2352x1568px.
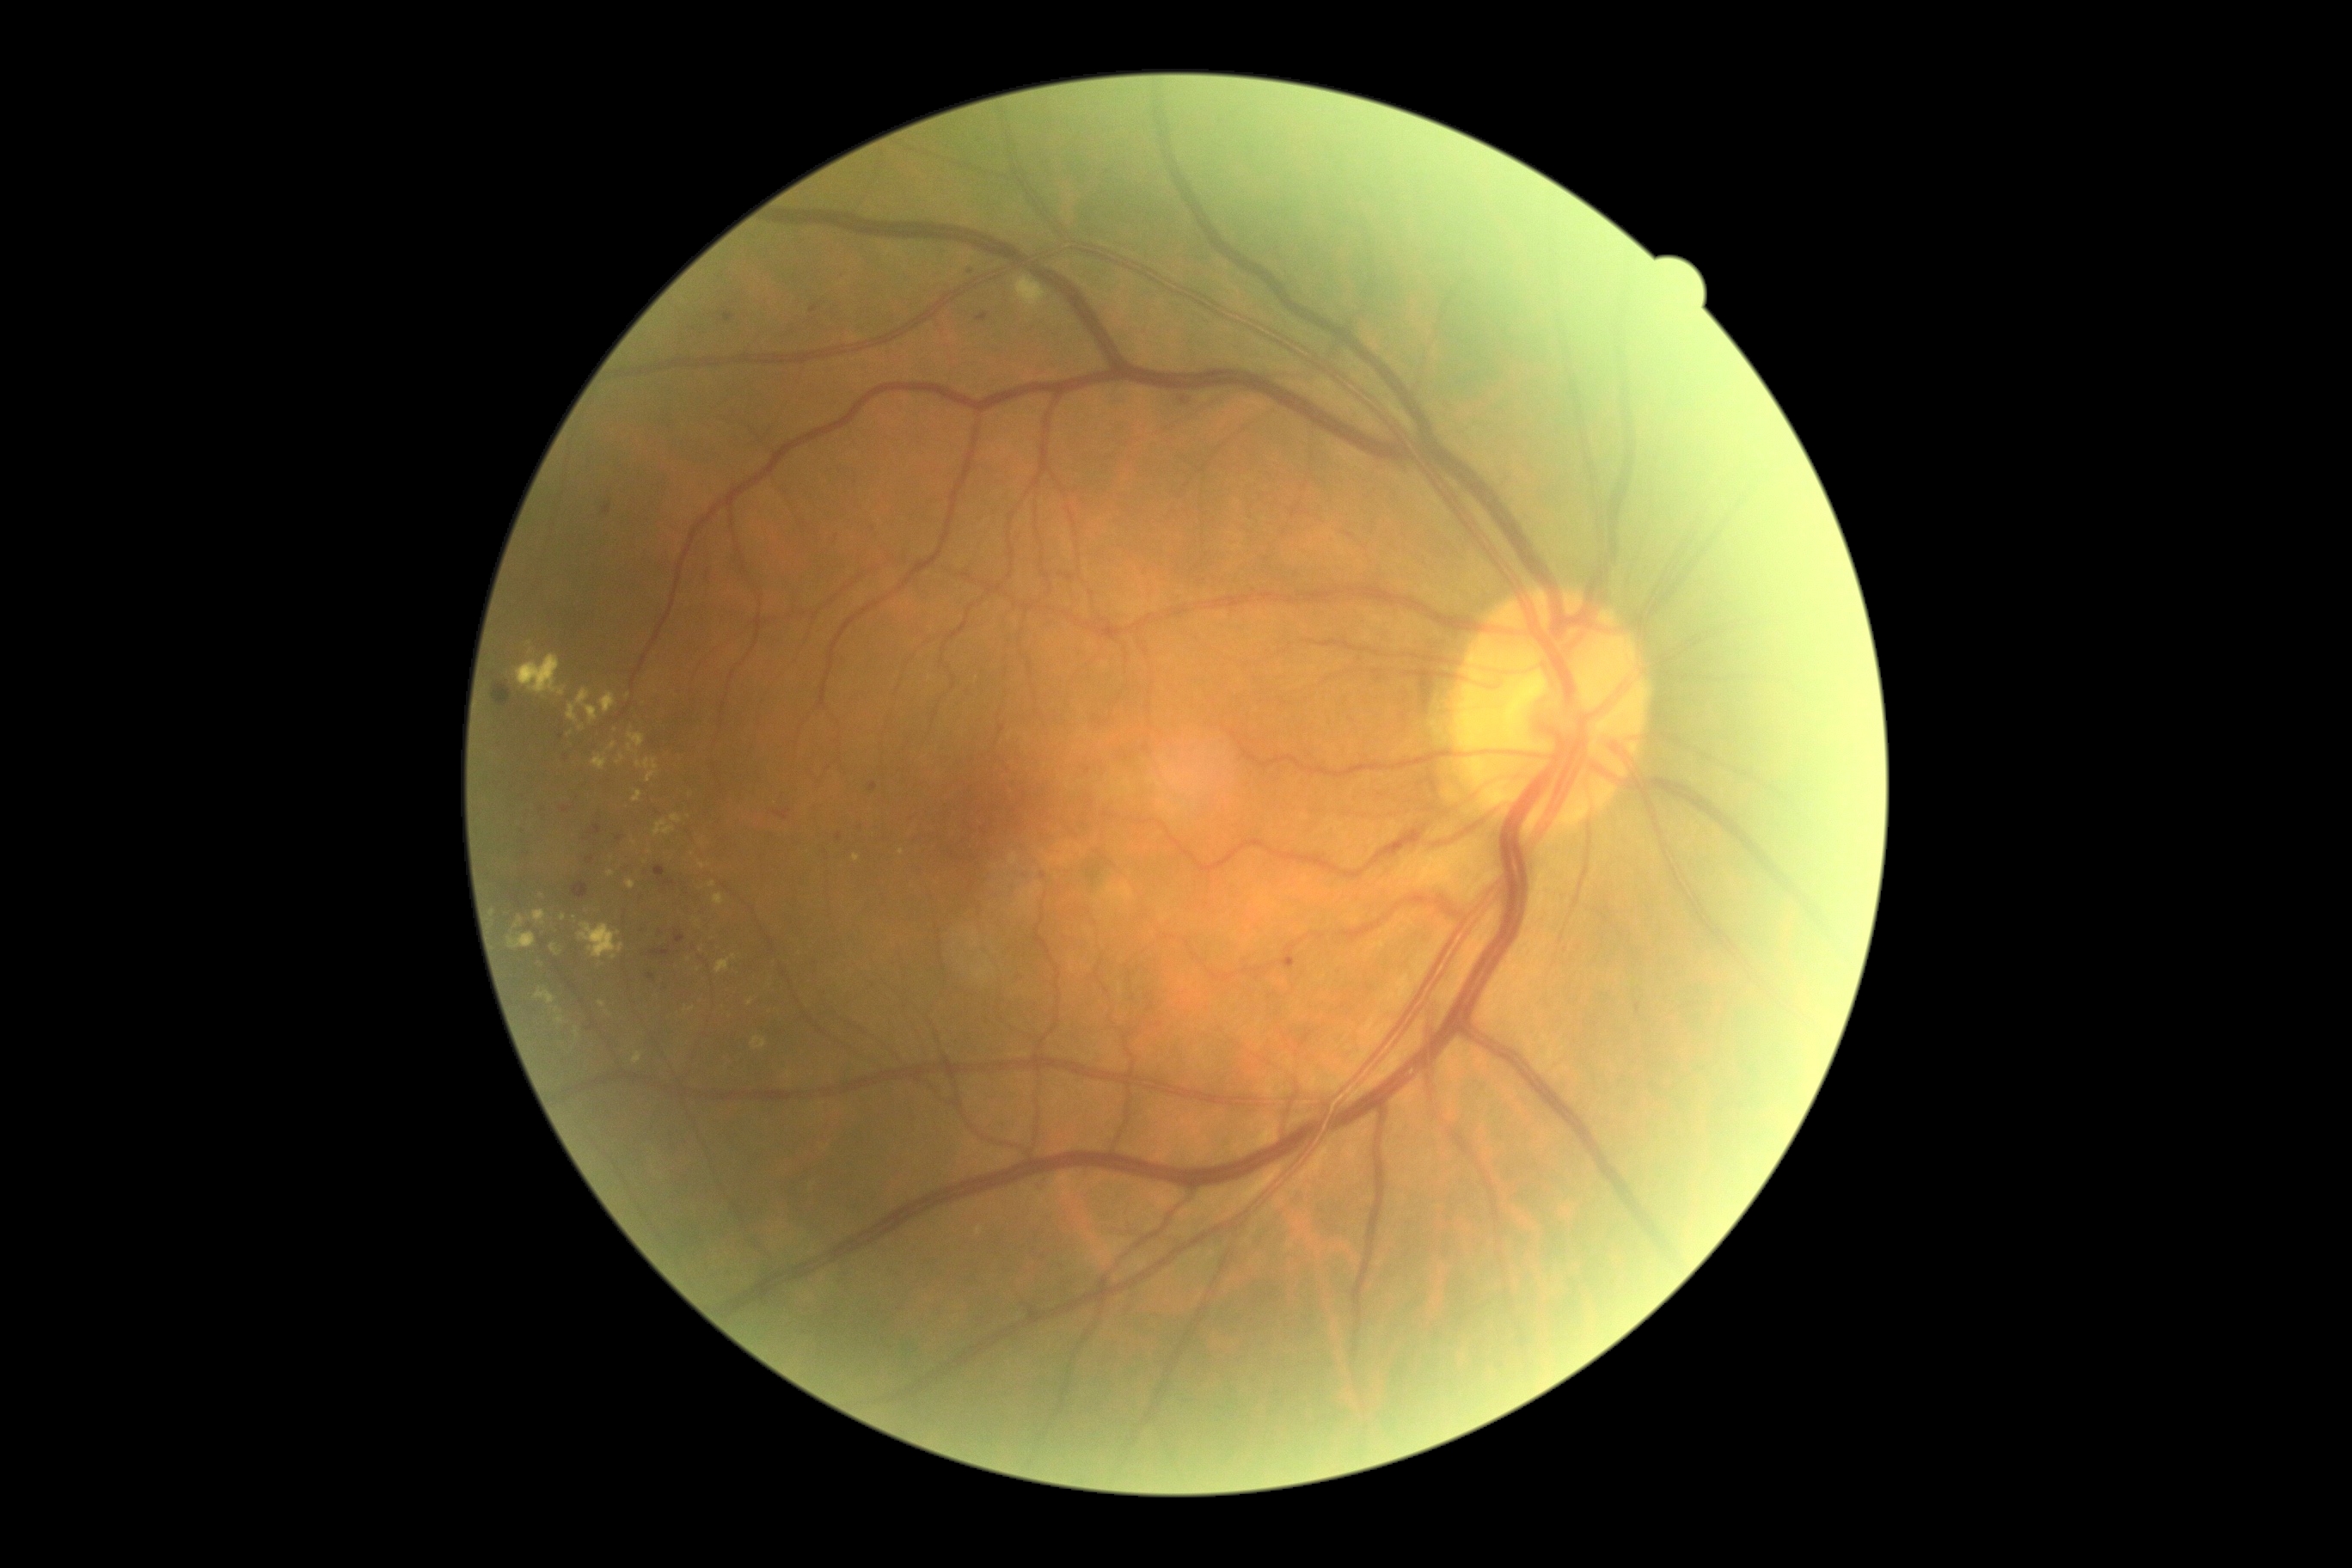
DR stage: grade 2 (moderate NPDR).